Clarity RetCam 3, 130° FOV; image size 640x480; RetCam wide-field infant fundus image — 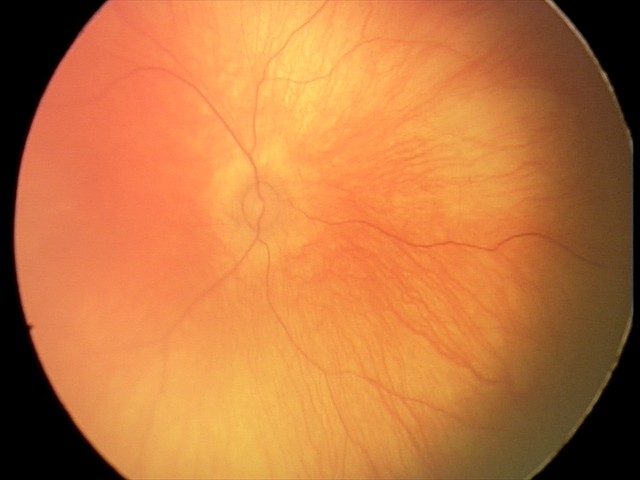

No retinal pathology identified on screening.